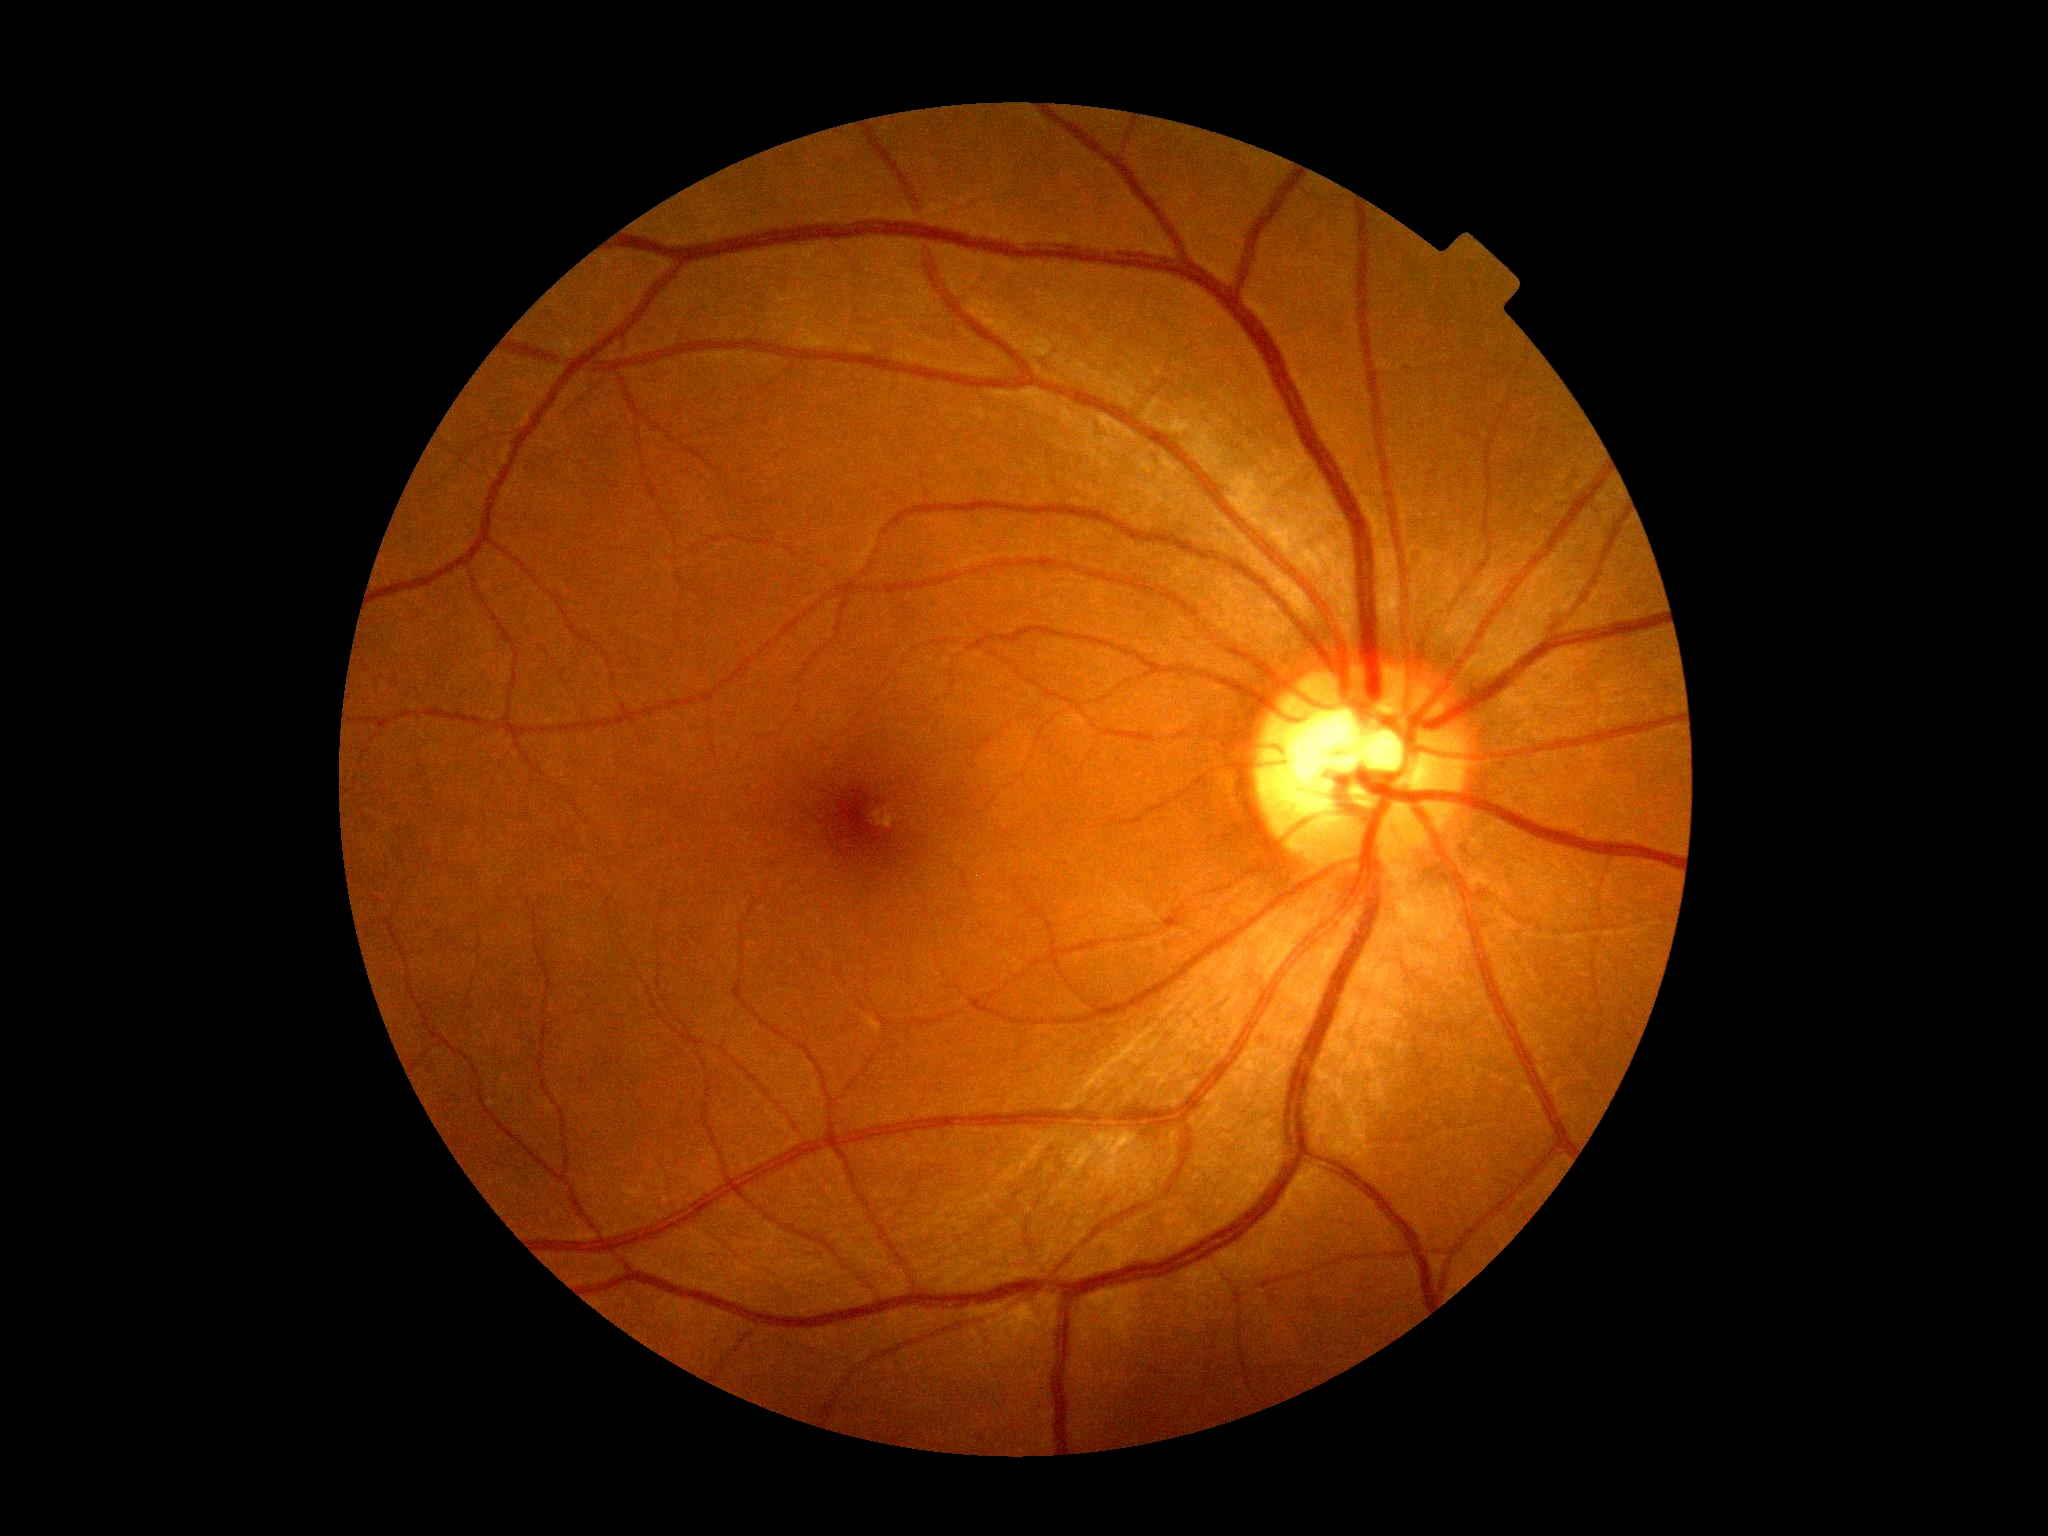

diabetic retinopathy grade: 0, DR impression: no signs of DR.